Acquired on the Phoenix ICON; pediatric wide-field fundus photograph — 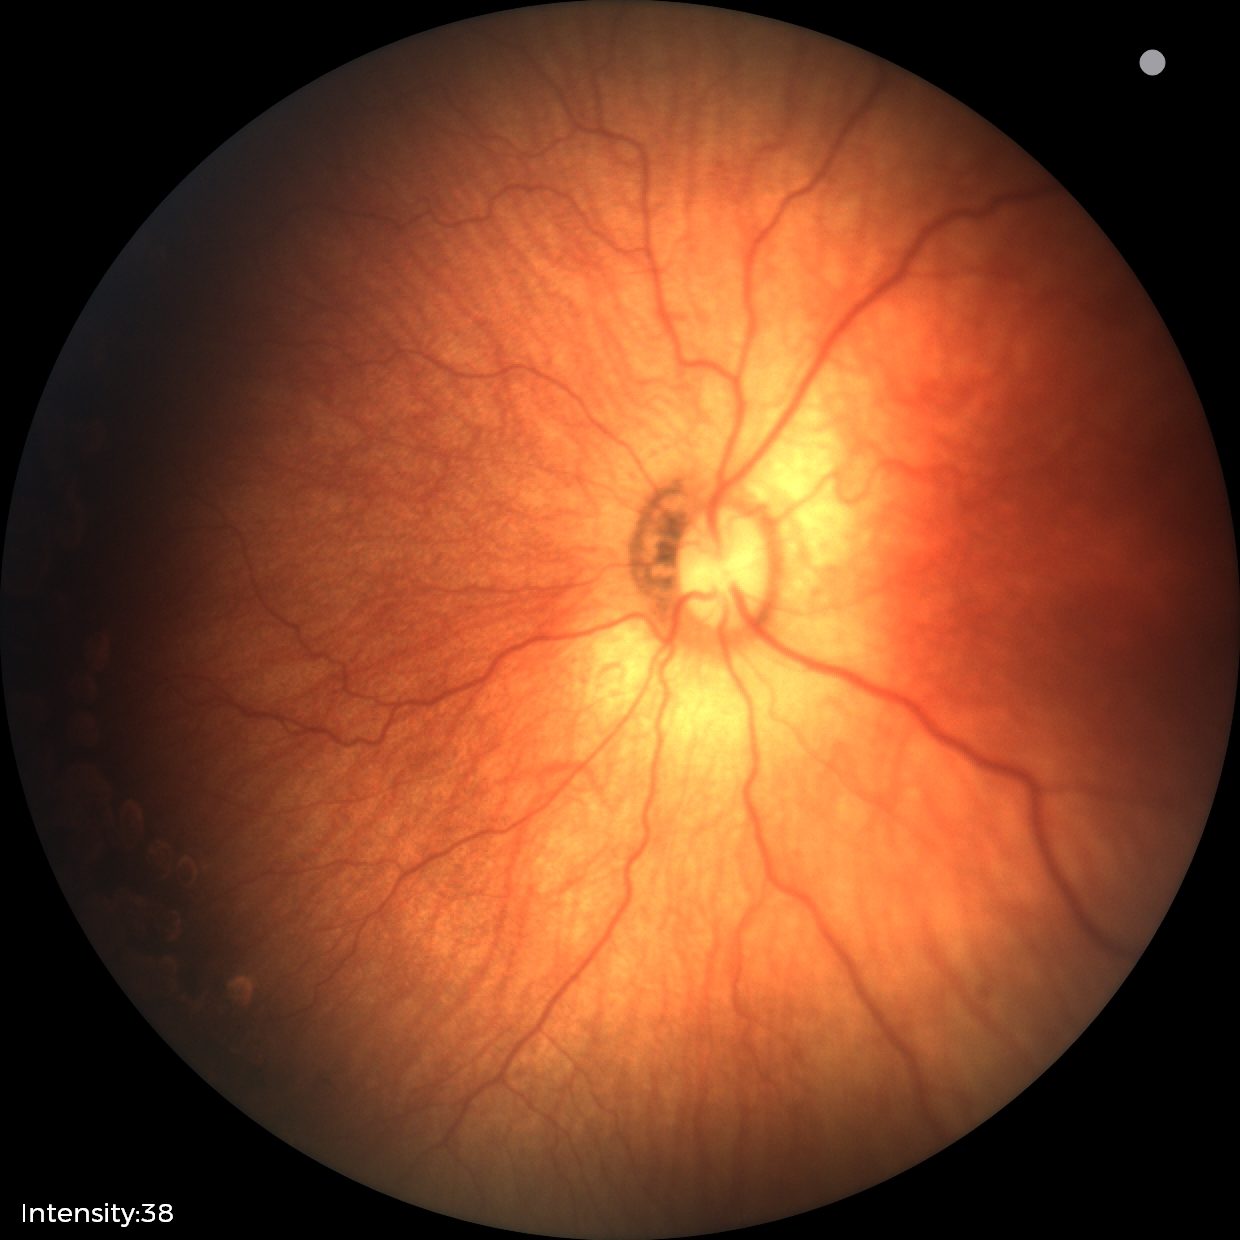

Without plus disease.
Diagnosis from this screening exam: status post ROP.